45° FOV · 2352x1568 · CFP.
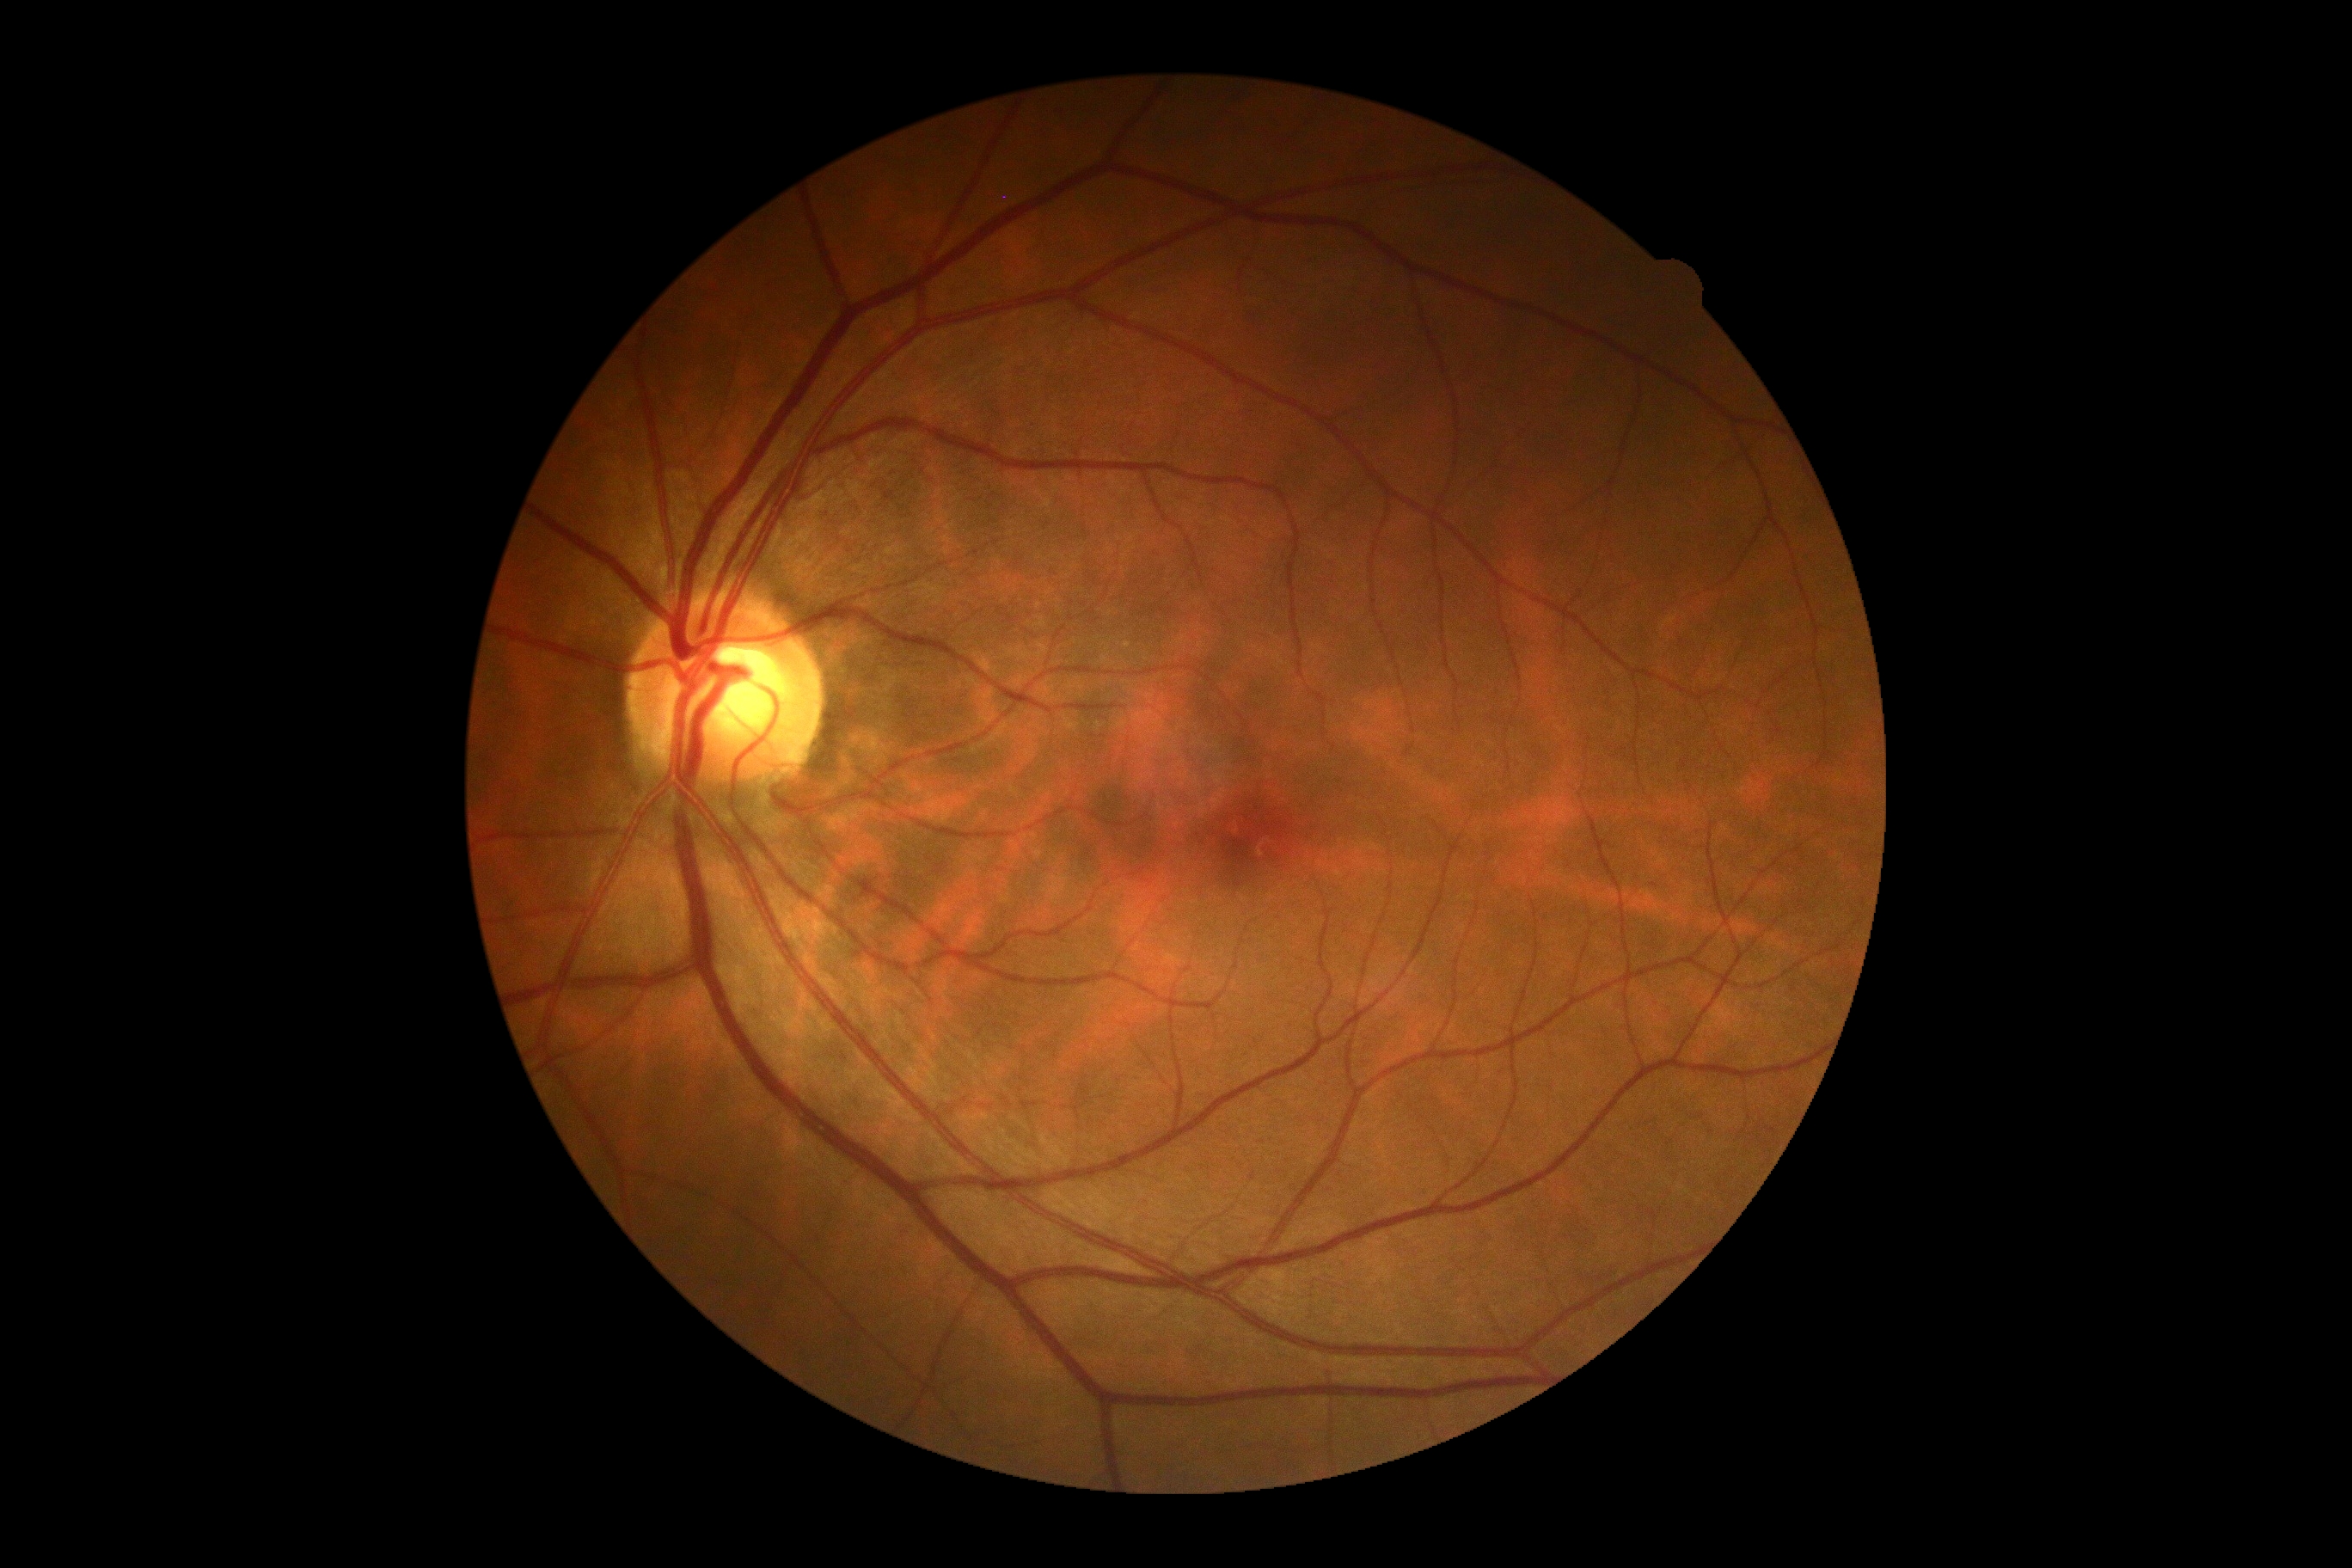
Diabetic retinopathy (DR) is no apparent retinopathy (grade 0) — no visible signs of diabetic retinopathy.